Infant wide-field retinal image: 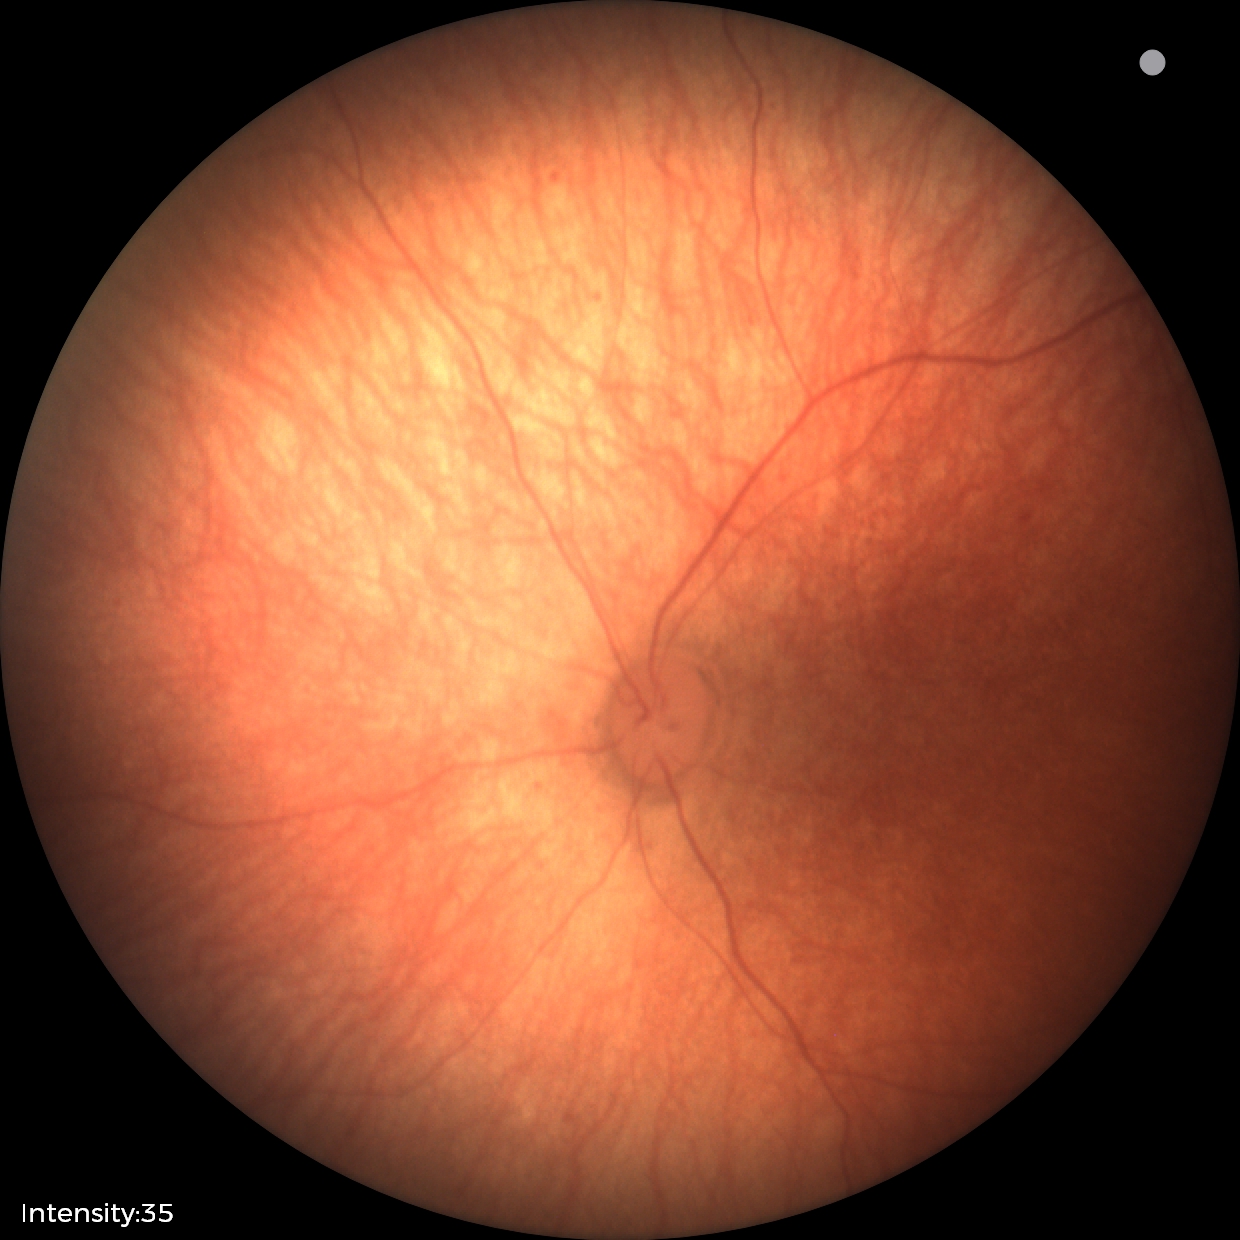

Physiological retinal appearance for postconceptual age.